Wide-field contact fundus photograph of an infant: 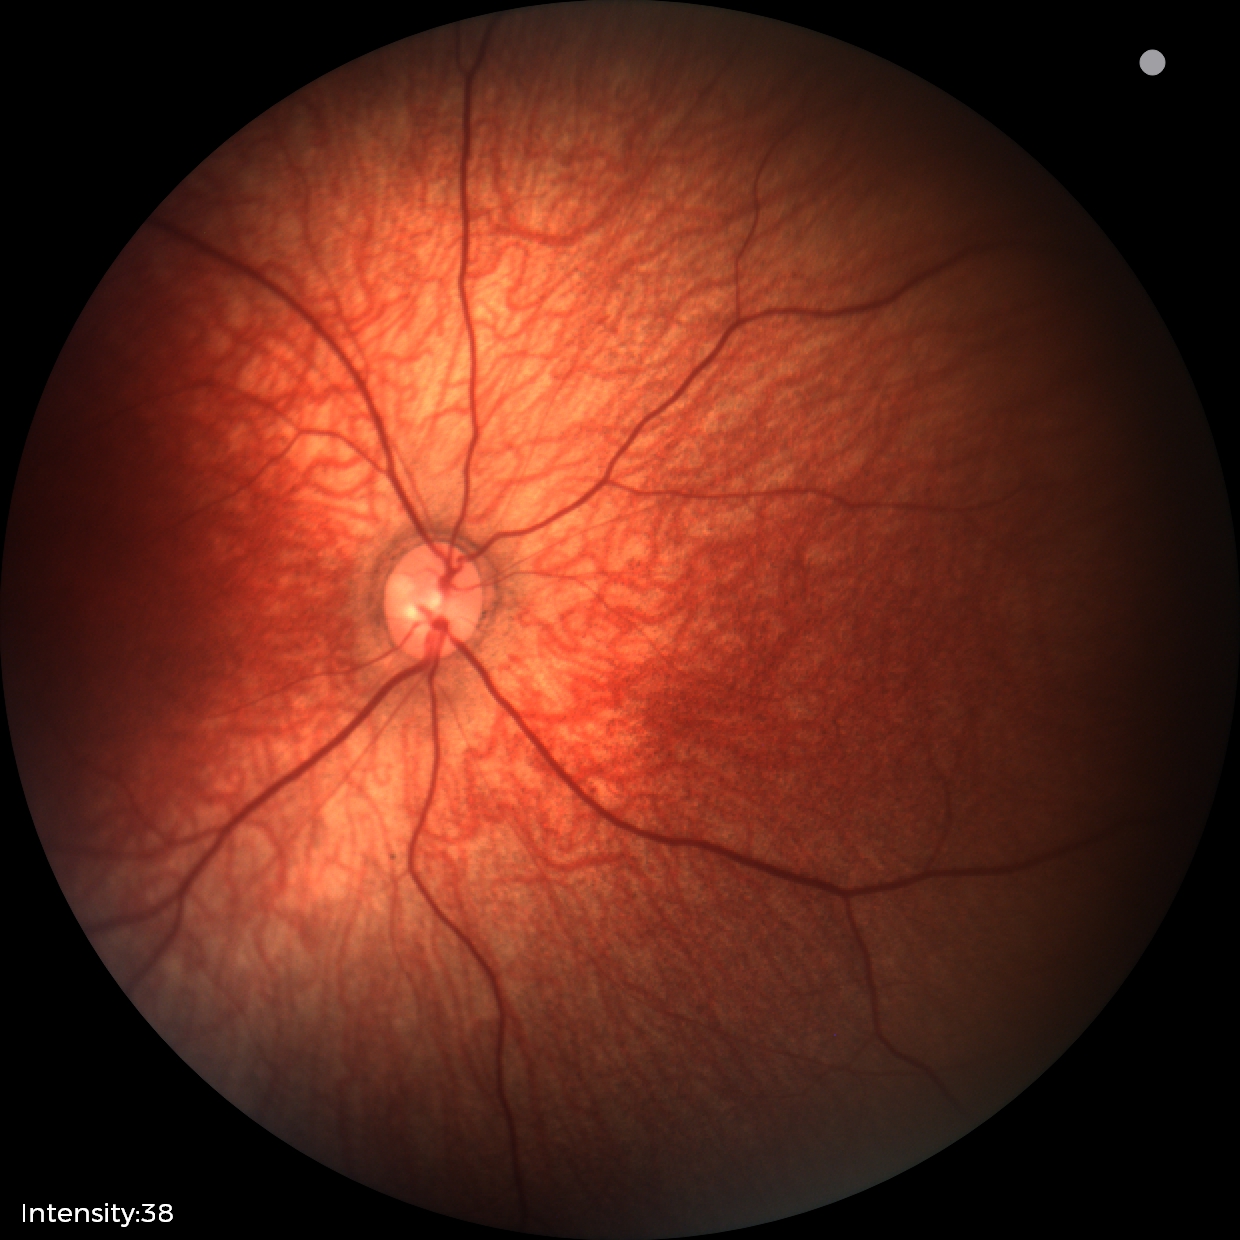 Examination with physiological retinal findings.